Nonmydriatic. NIDEK AFC-230 fundus camera:
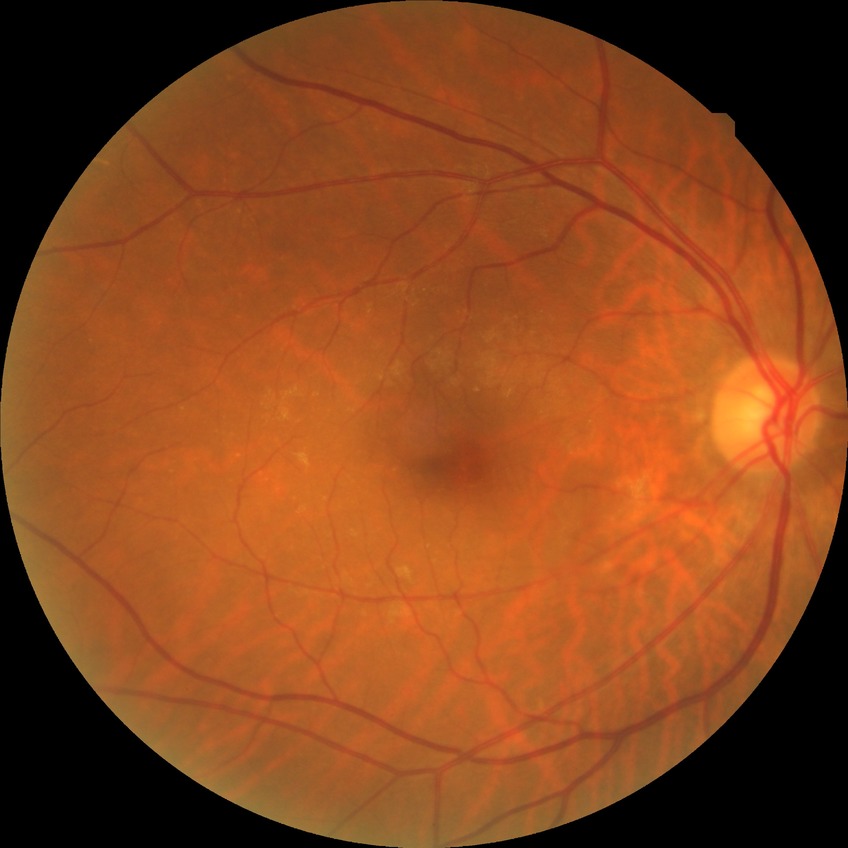

Diabetic retinopathy (DR) is no diabetic retinopathy (NDR).